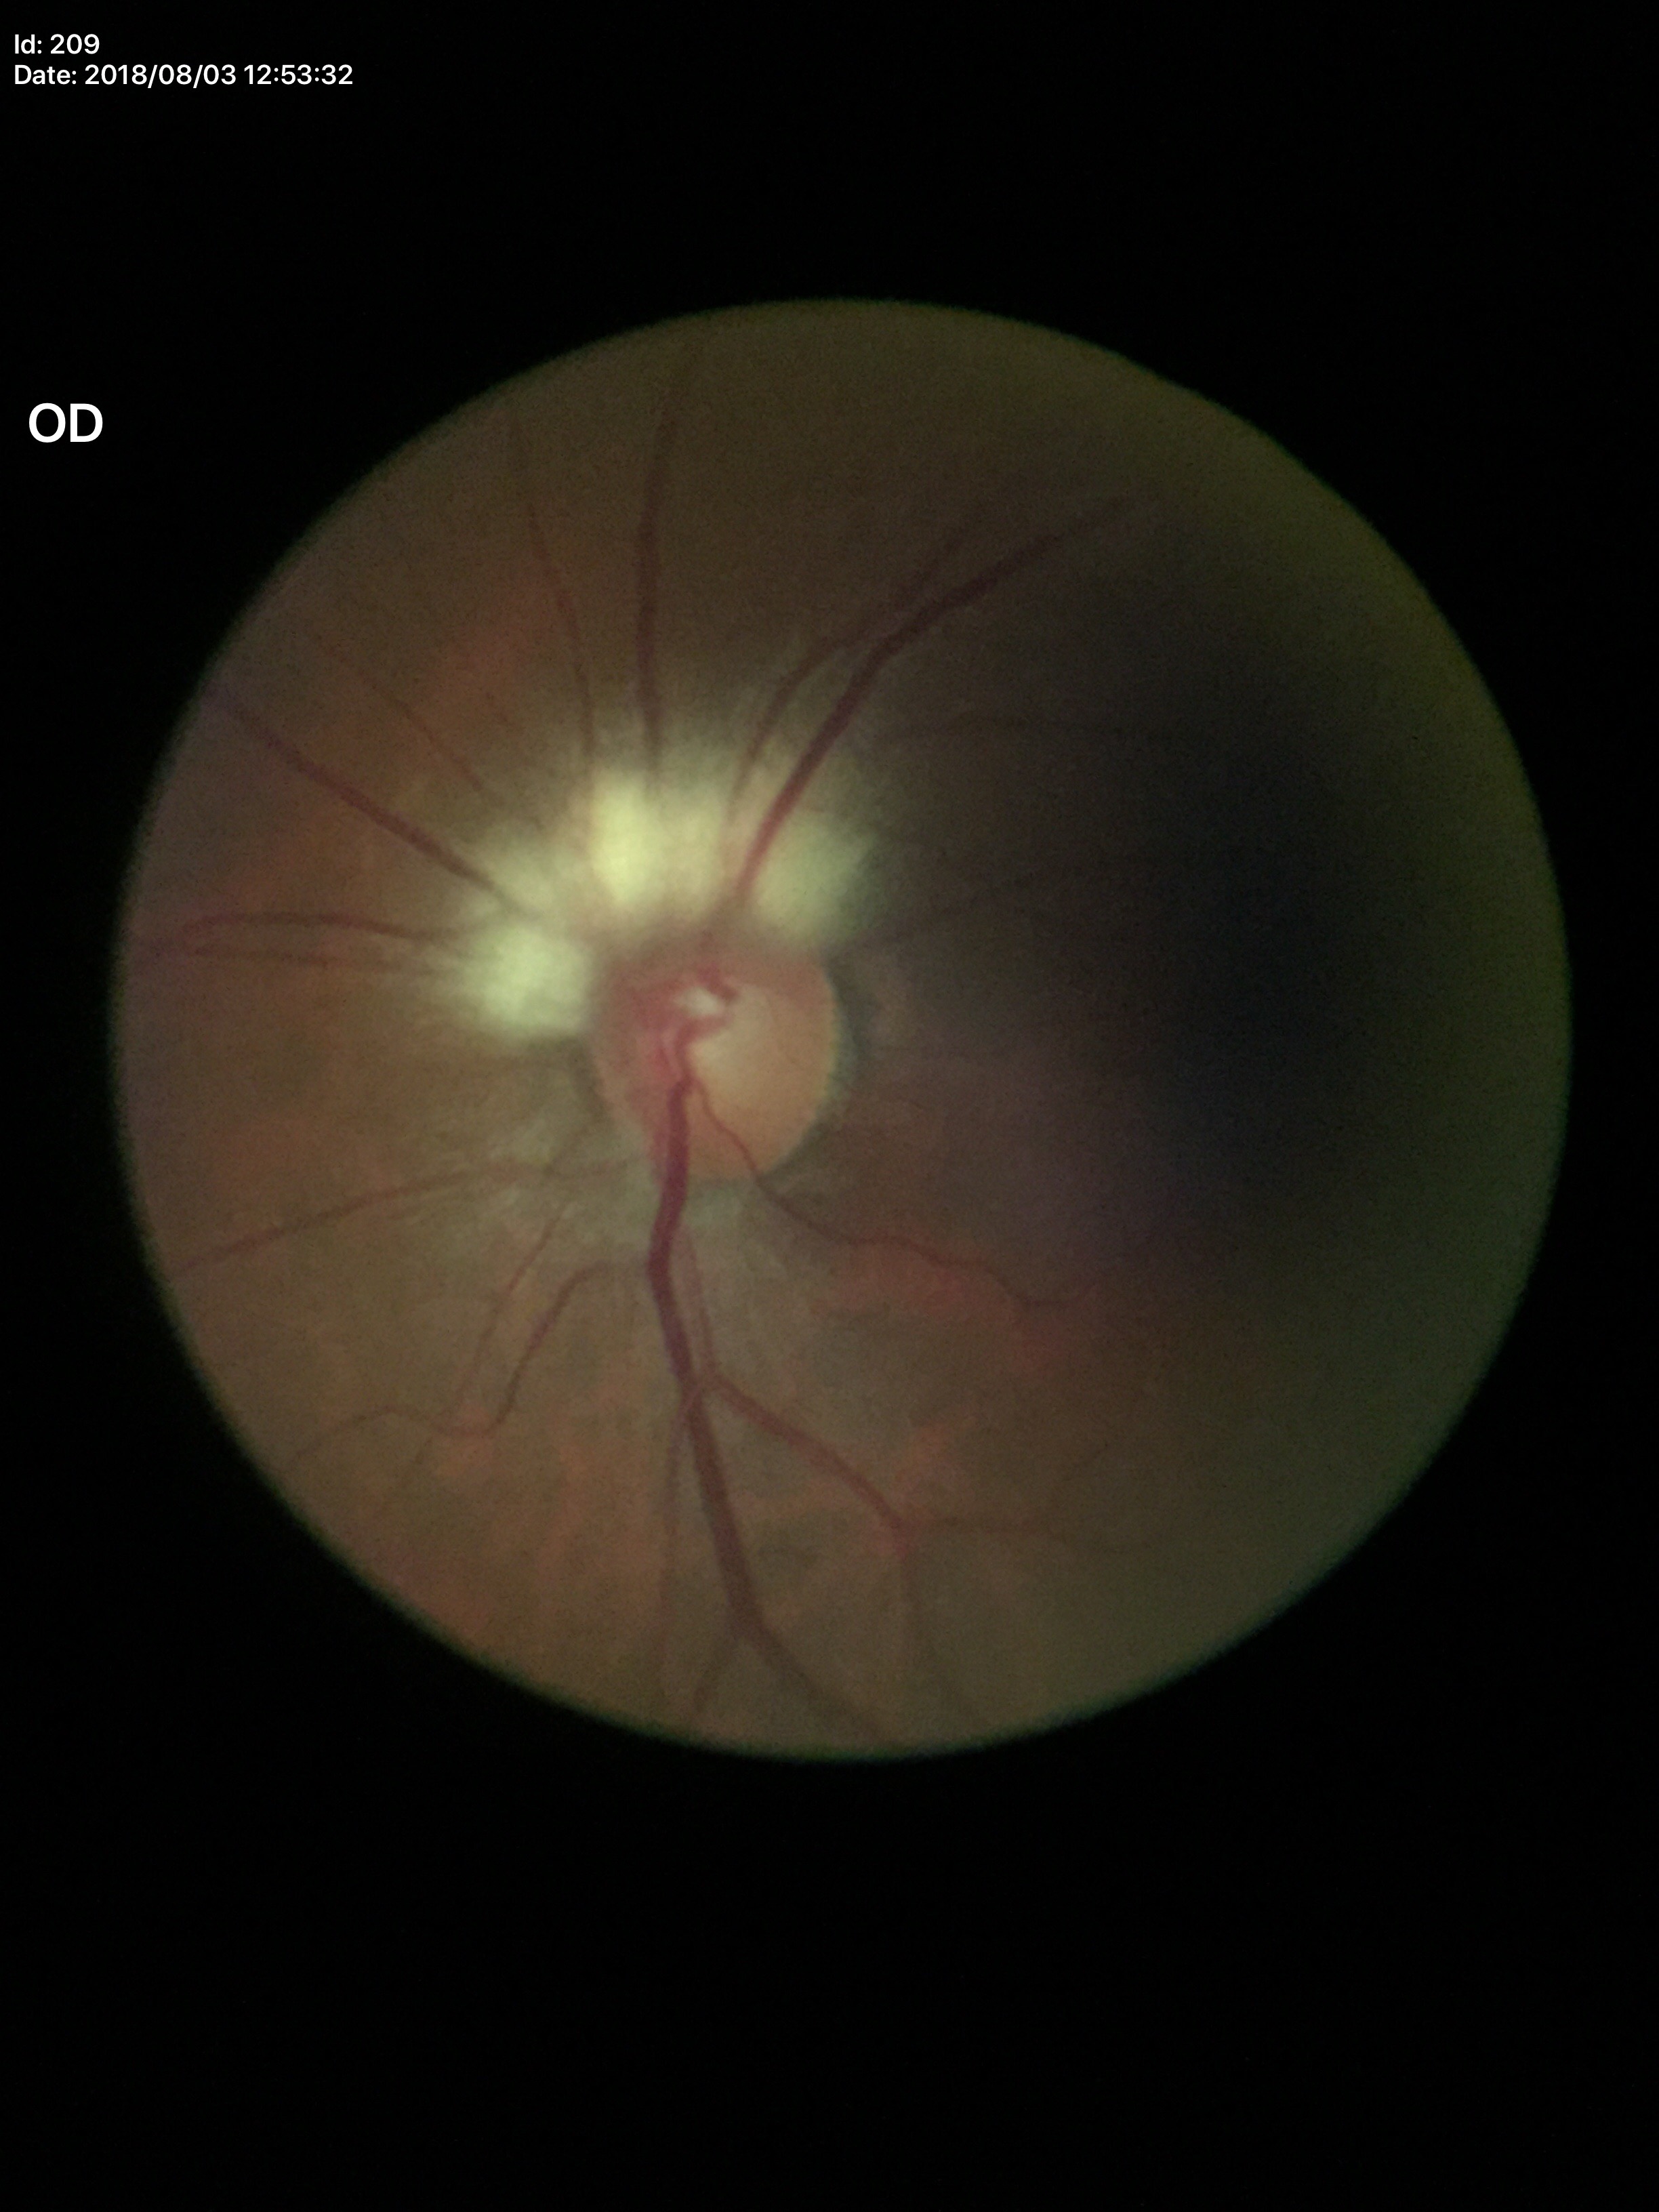
Glaucoma assessment = no suspicious findings | vertical cup-disc ratio (VCDR) = 0.55.